1536x1152 · FOV: 45 degrees — 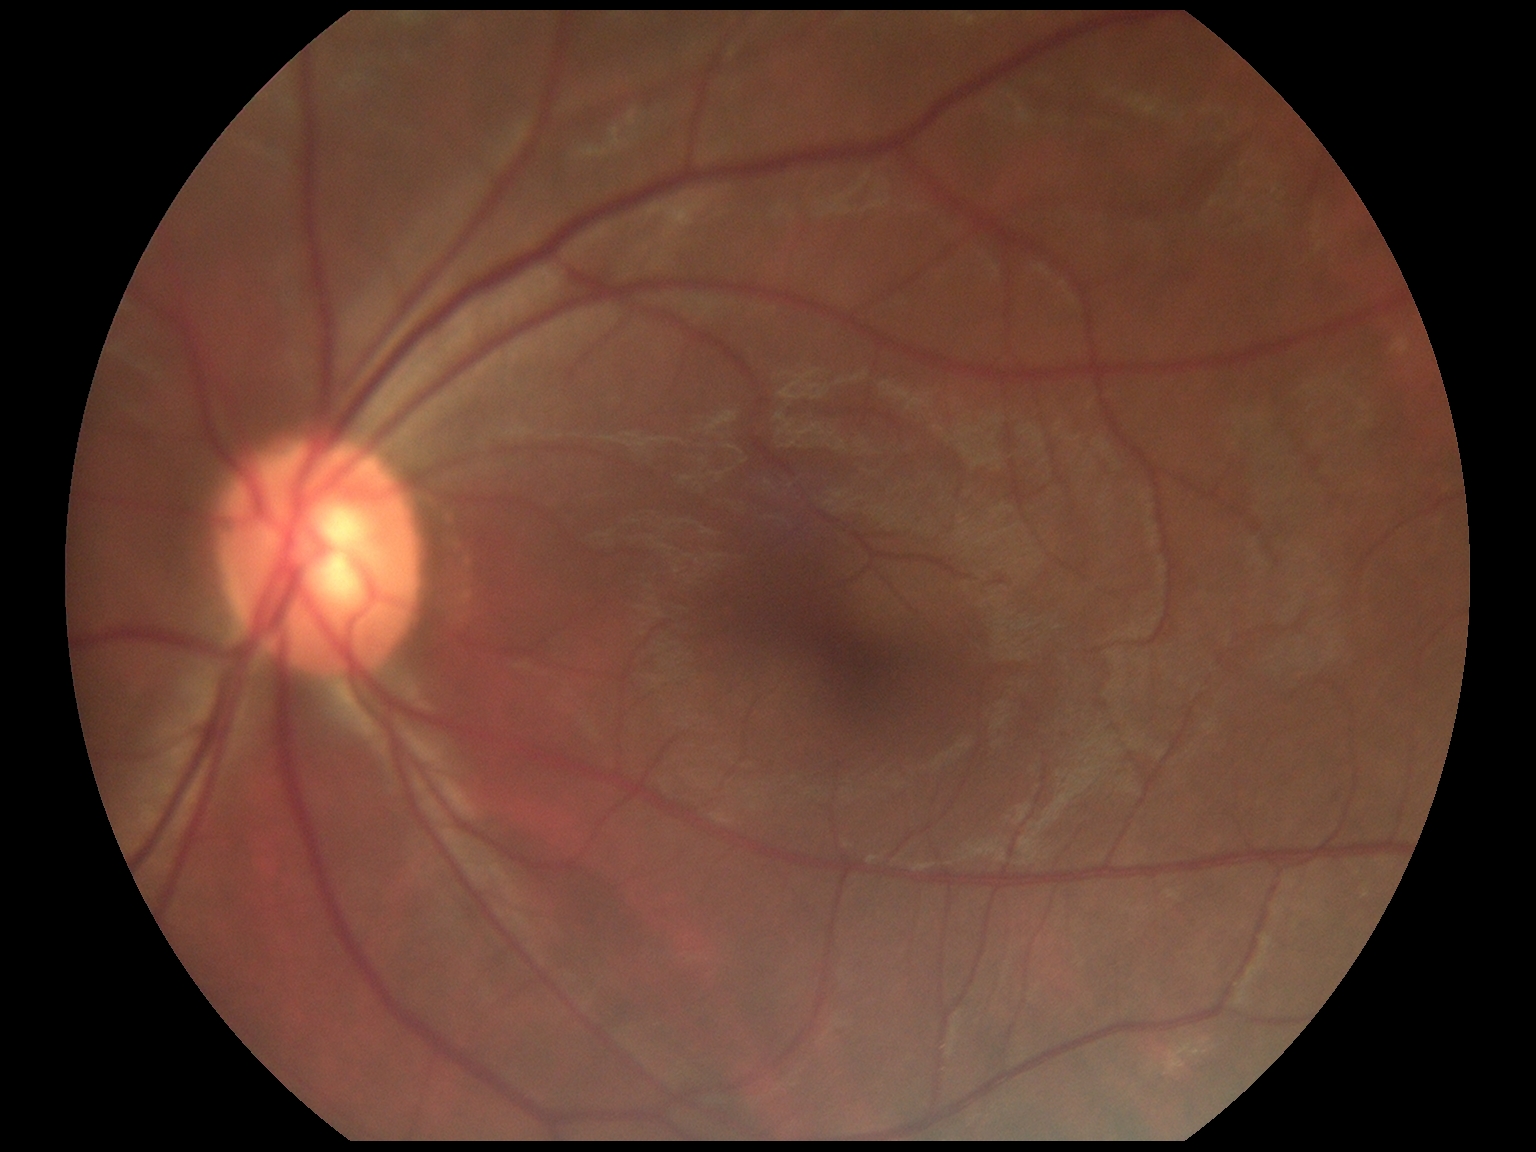

DR impression: no signs of DR, DR severity: no apparent diabetic retinopathy (grade 0).